Retinal fundus photograph: 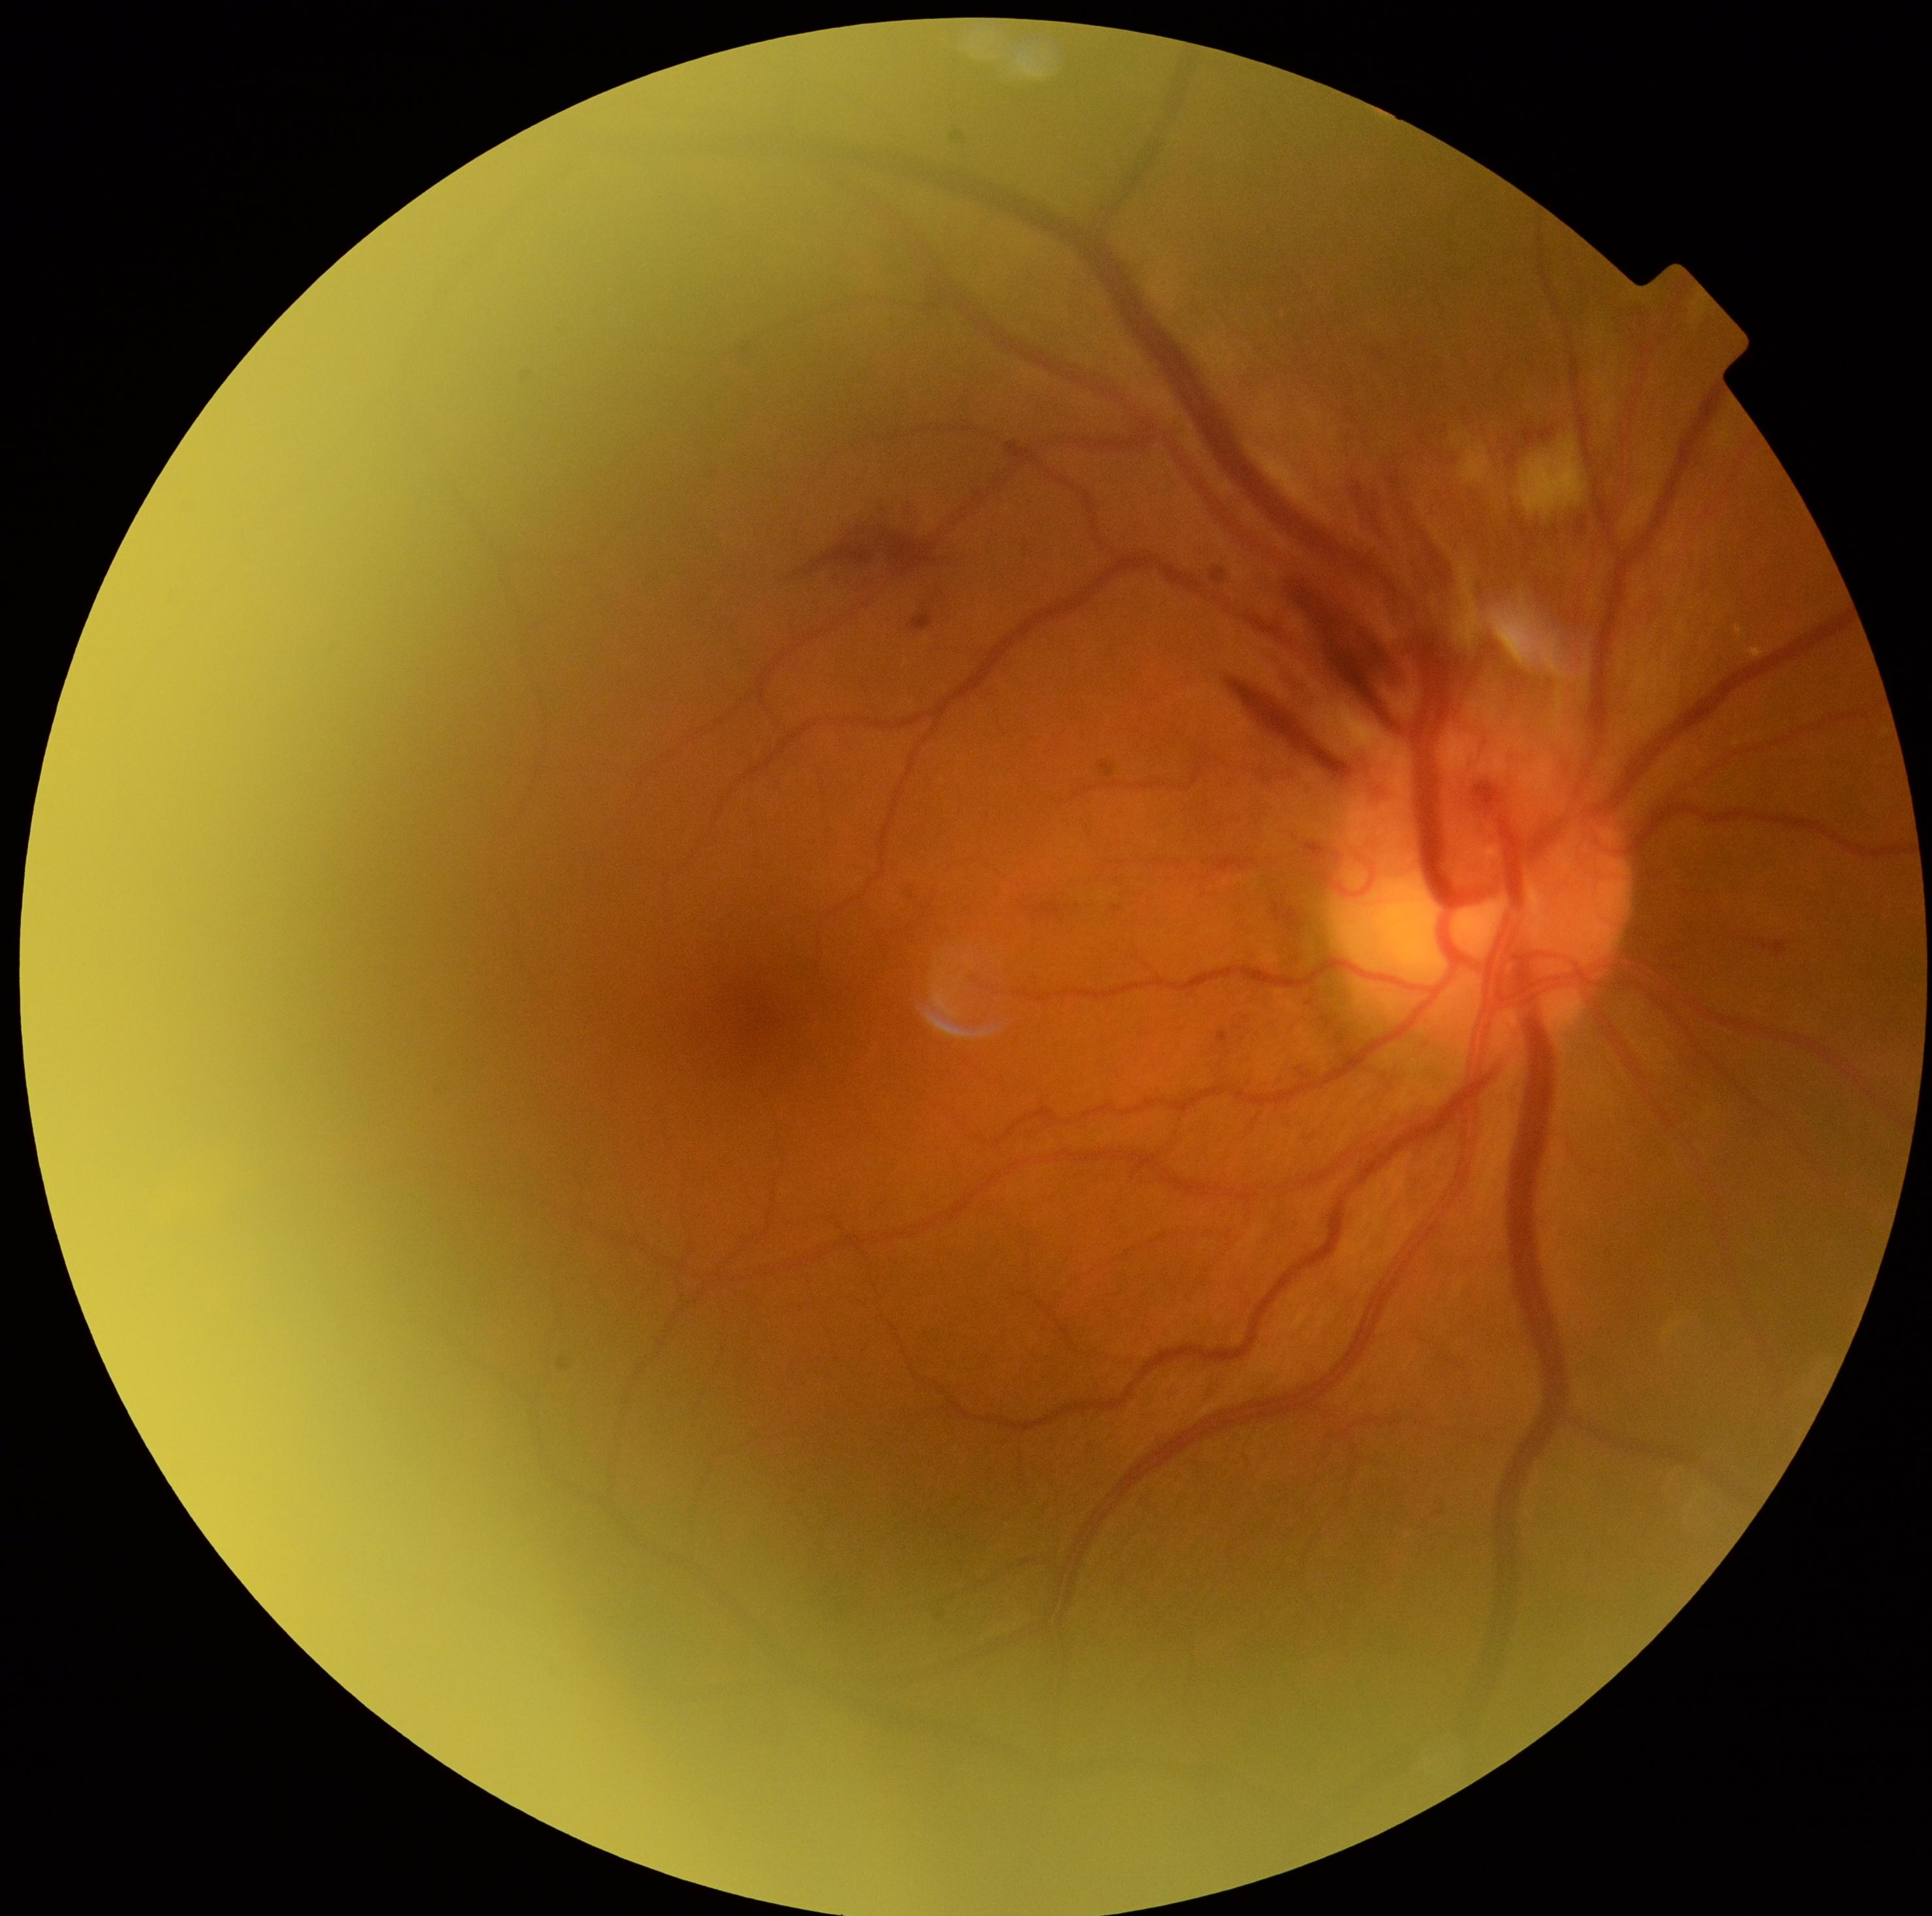 • diabetic retinopathy severity — 2/4